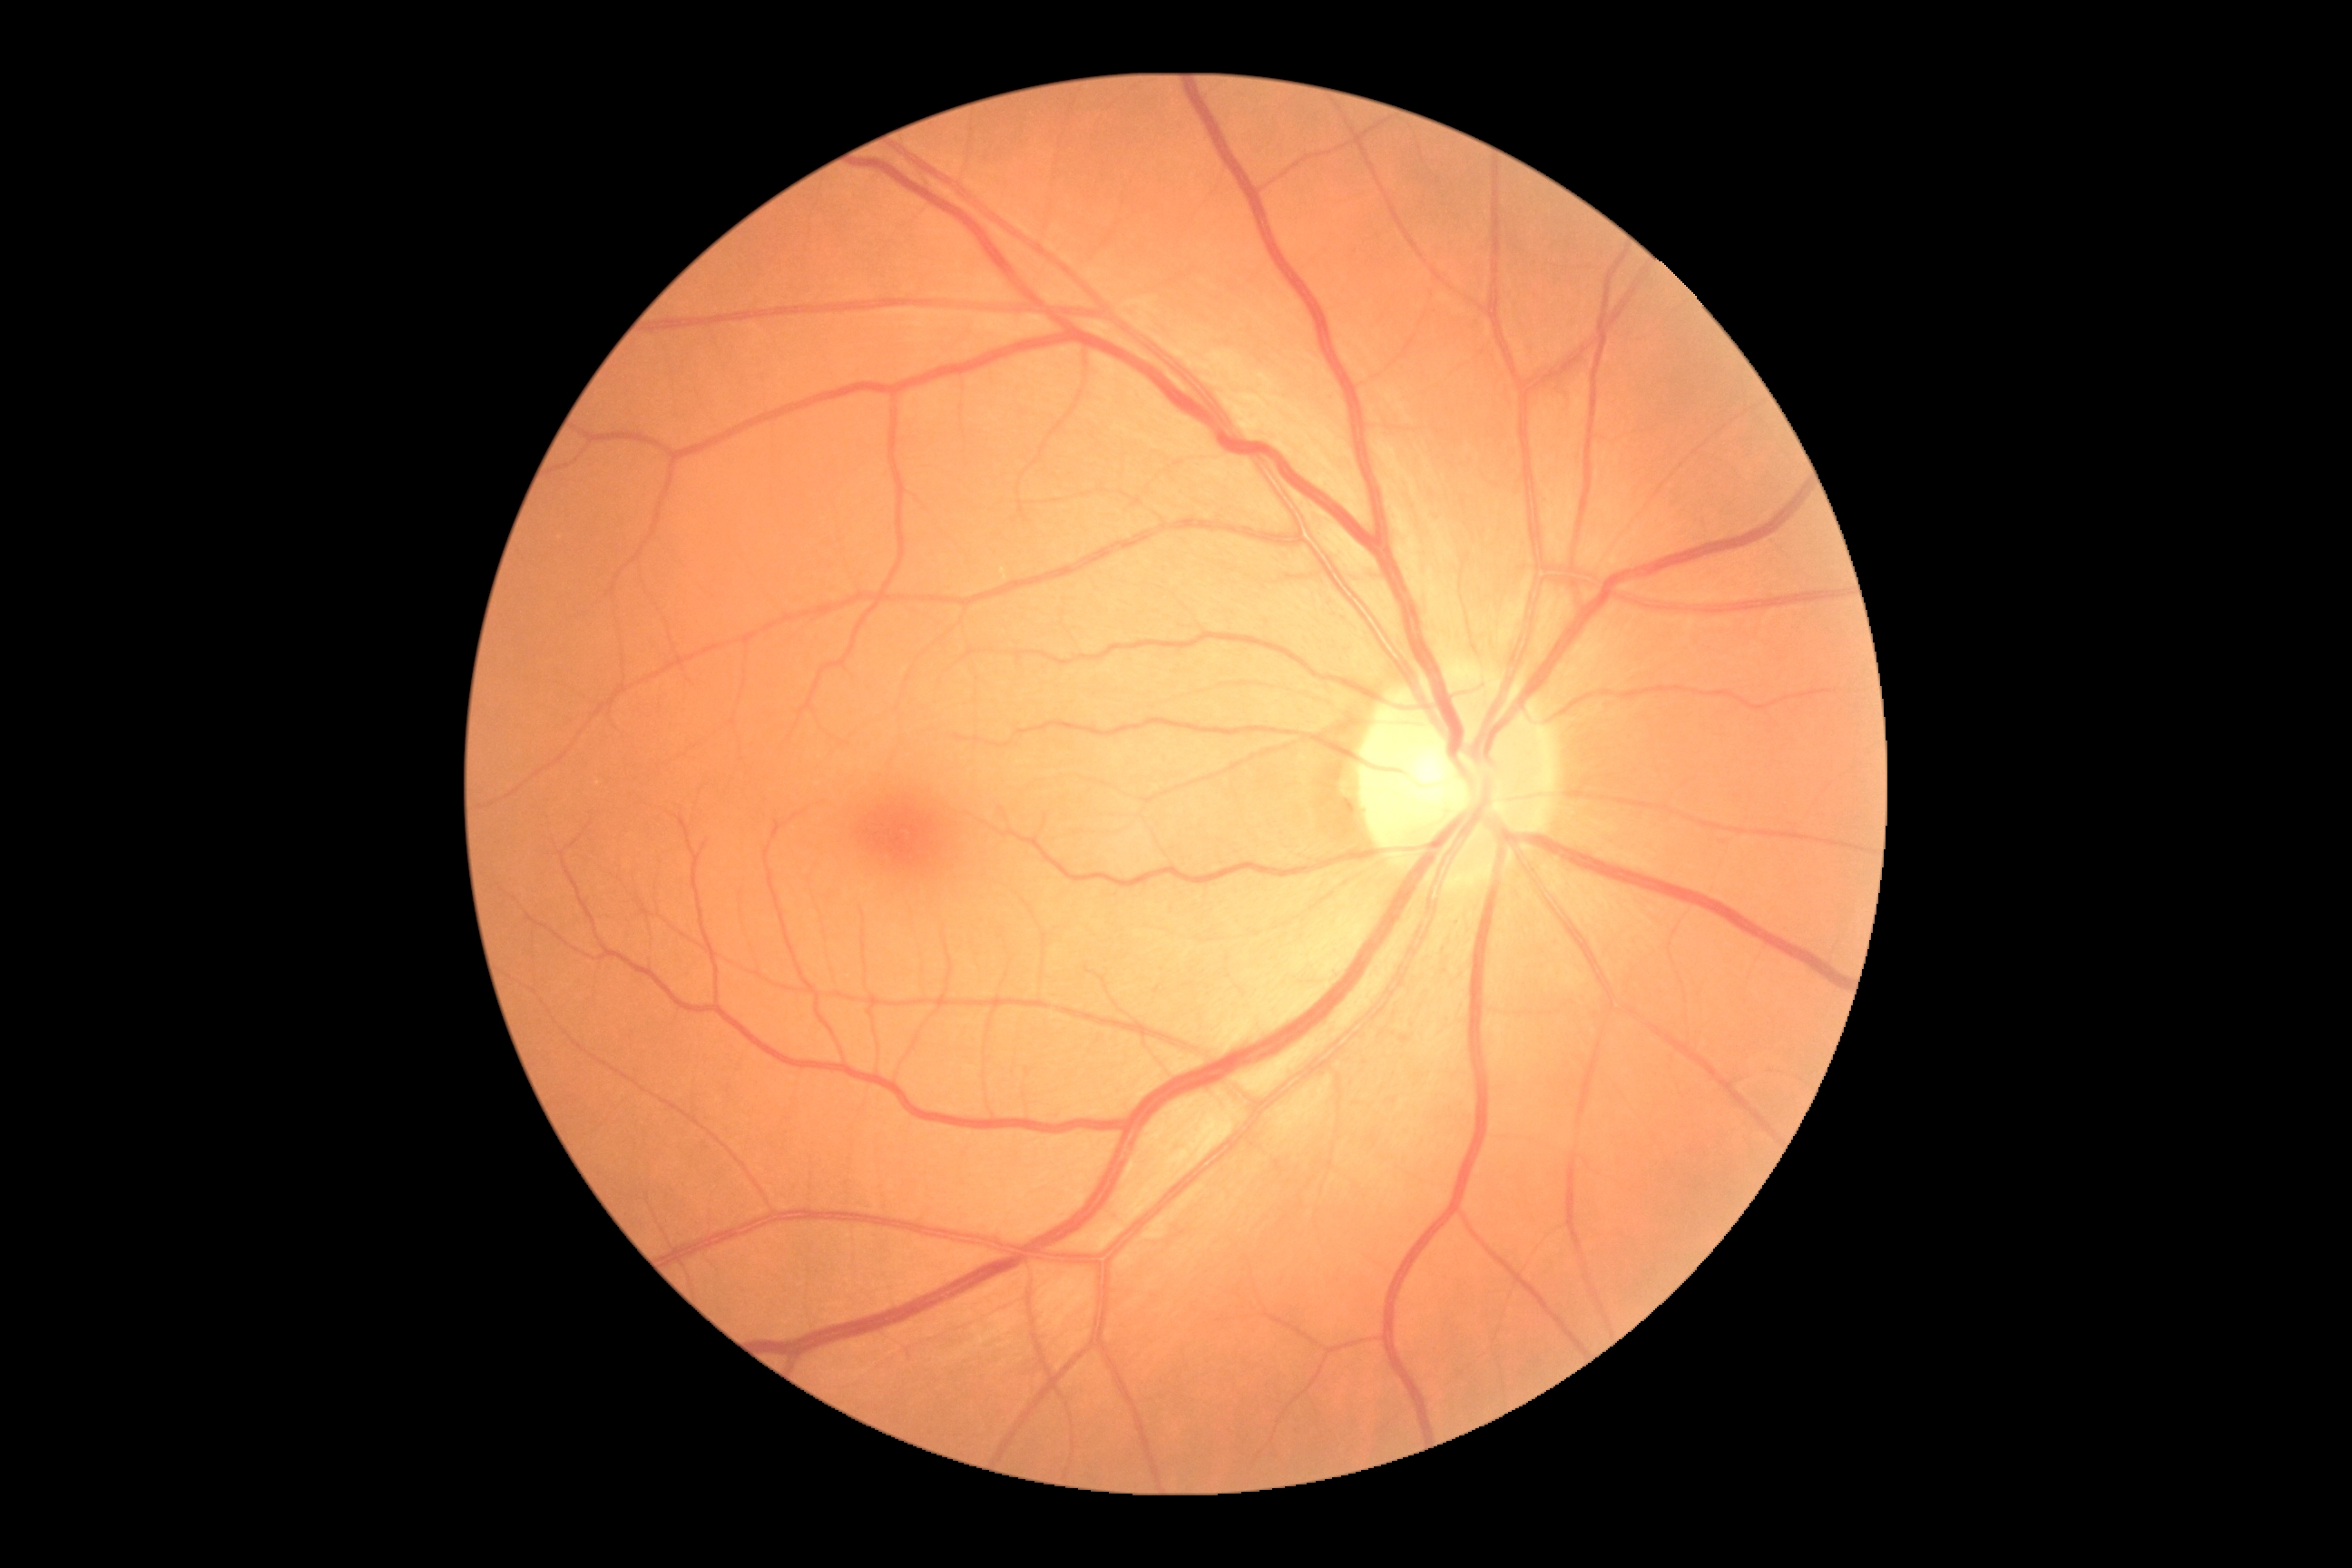 DR grade: 0. No apparent diabetic retinopathy.